Image size 848x848 · modified Davis grading — 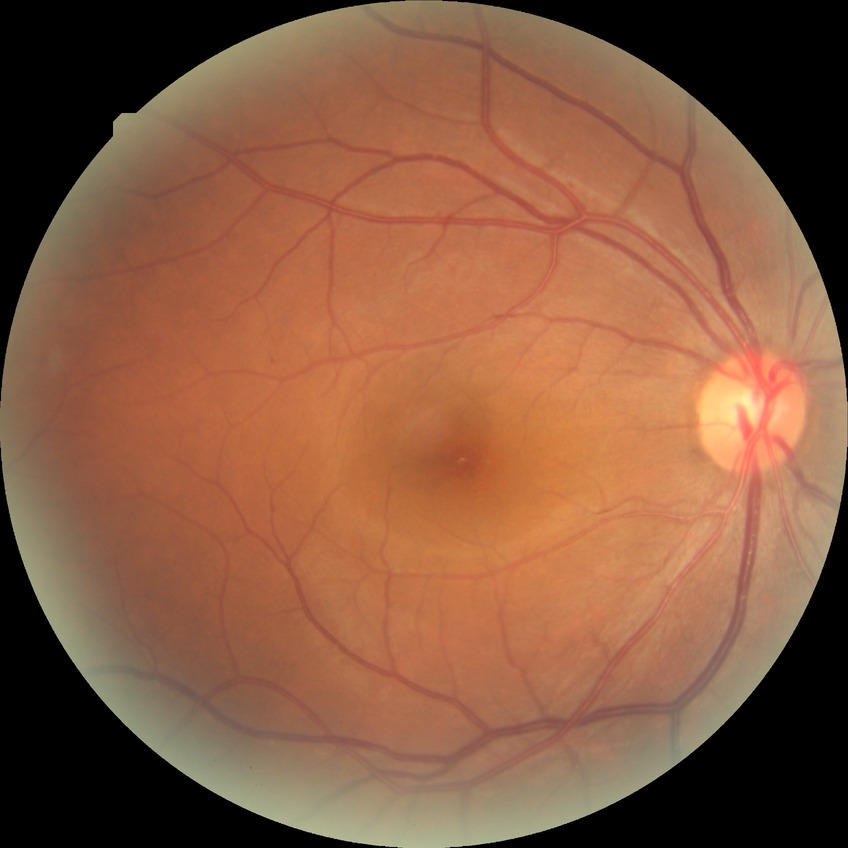
diabetic retinopathy (DR)@SDR (simple diabetic retinopathy).